2212x1659. 45-degree field of view. Fundus photo:
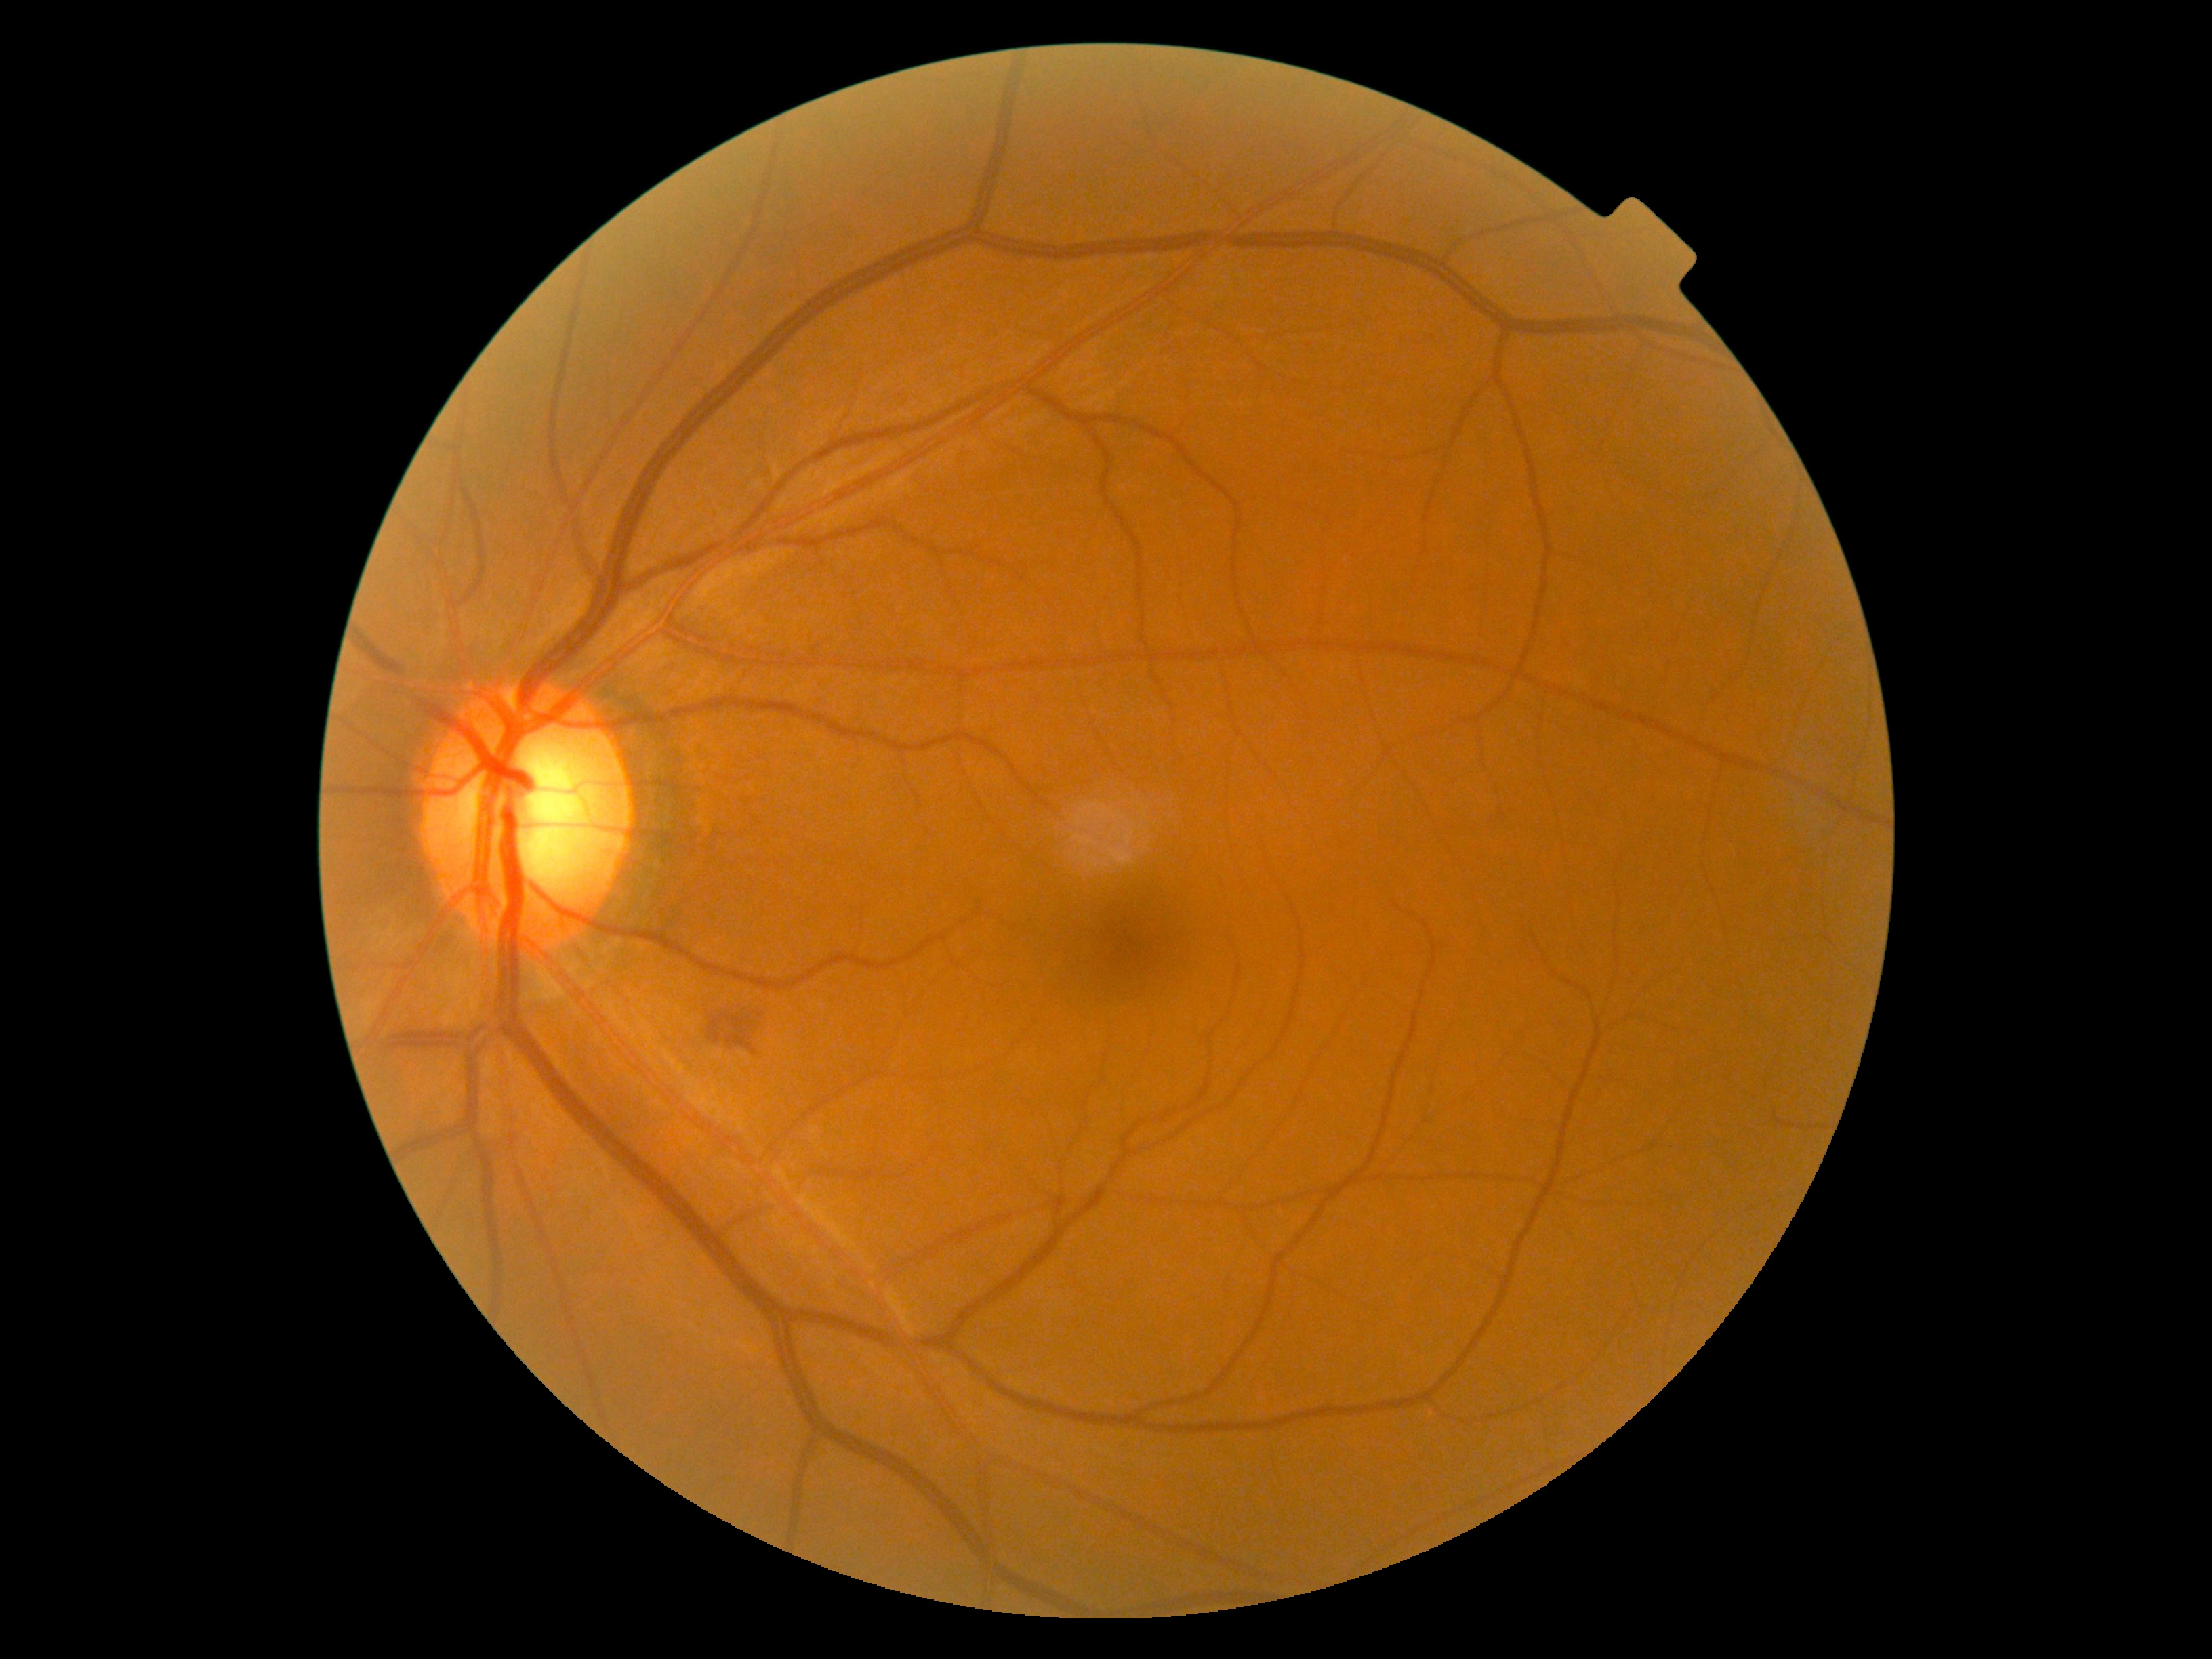

DR stage: grade 2, DR class: non-proliferative diabetic retinopathy.